2212 by 1659 pixels — 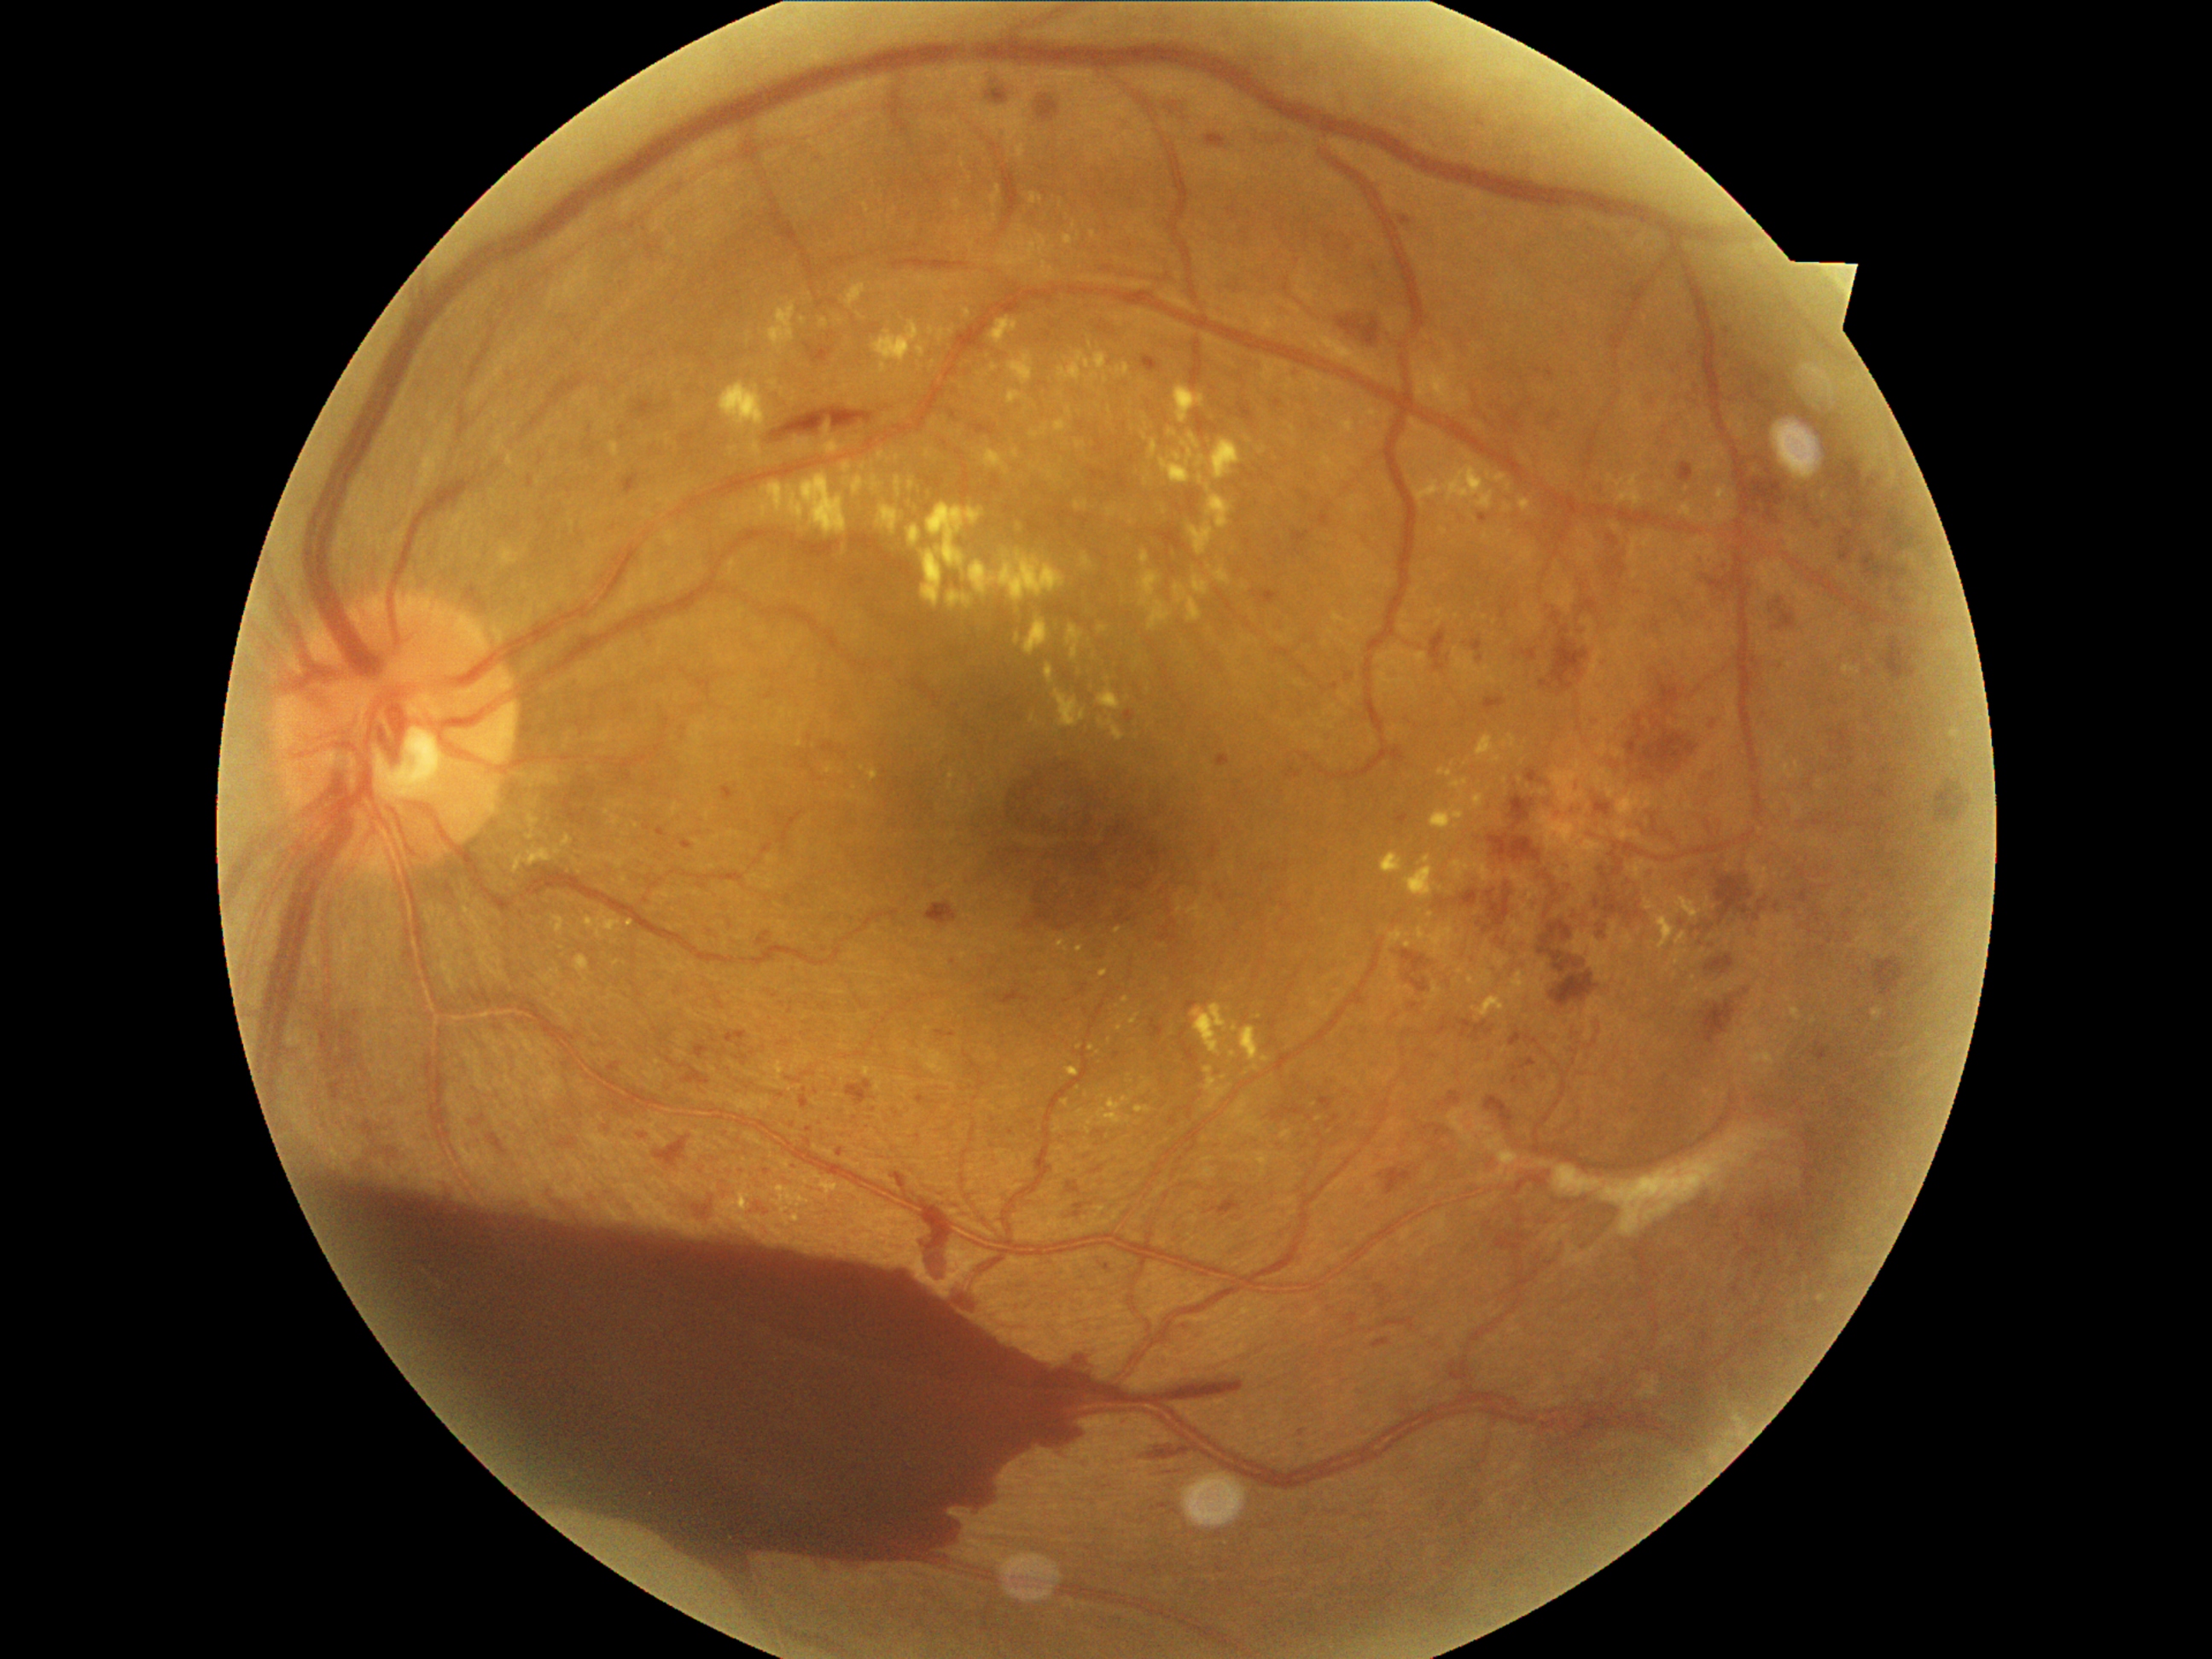 DR is grade 4
A subset of detected lesions:
EXs (partial): region(1141, 1080, 1151, 1090) | region(1341, 421, 1354, 434) | region(719, 381, 765, 431) | region(1078, 1110, 1086, 1119) | region(1124, 996, 1131, 1004) | region(1062, 236, 1074, 247) | region(1168, 429, 1179, 438) | region(1472, 863, 1503, 883) | region(936, 330, 955, 344) | region(501, 547, 520, 566) | region(1008, 352, 1035, 385) | region(1211, 439, 1242, 482) | region(1438, 769, 1453, 779)
Small EXs near pt(1467, 764) | pt(803, 321) | pt(1506, 781) | pt(1059, 476) | pt(840, 321) | pt(1118, 931)